Color fundus photograph: 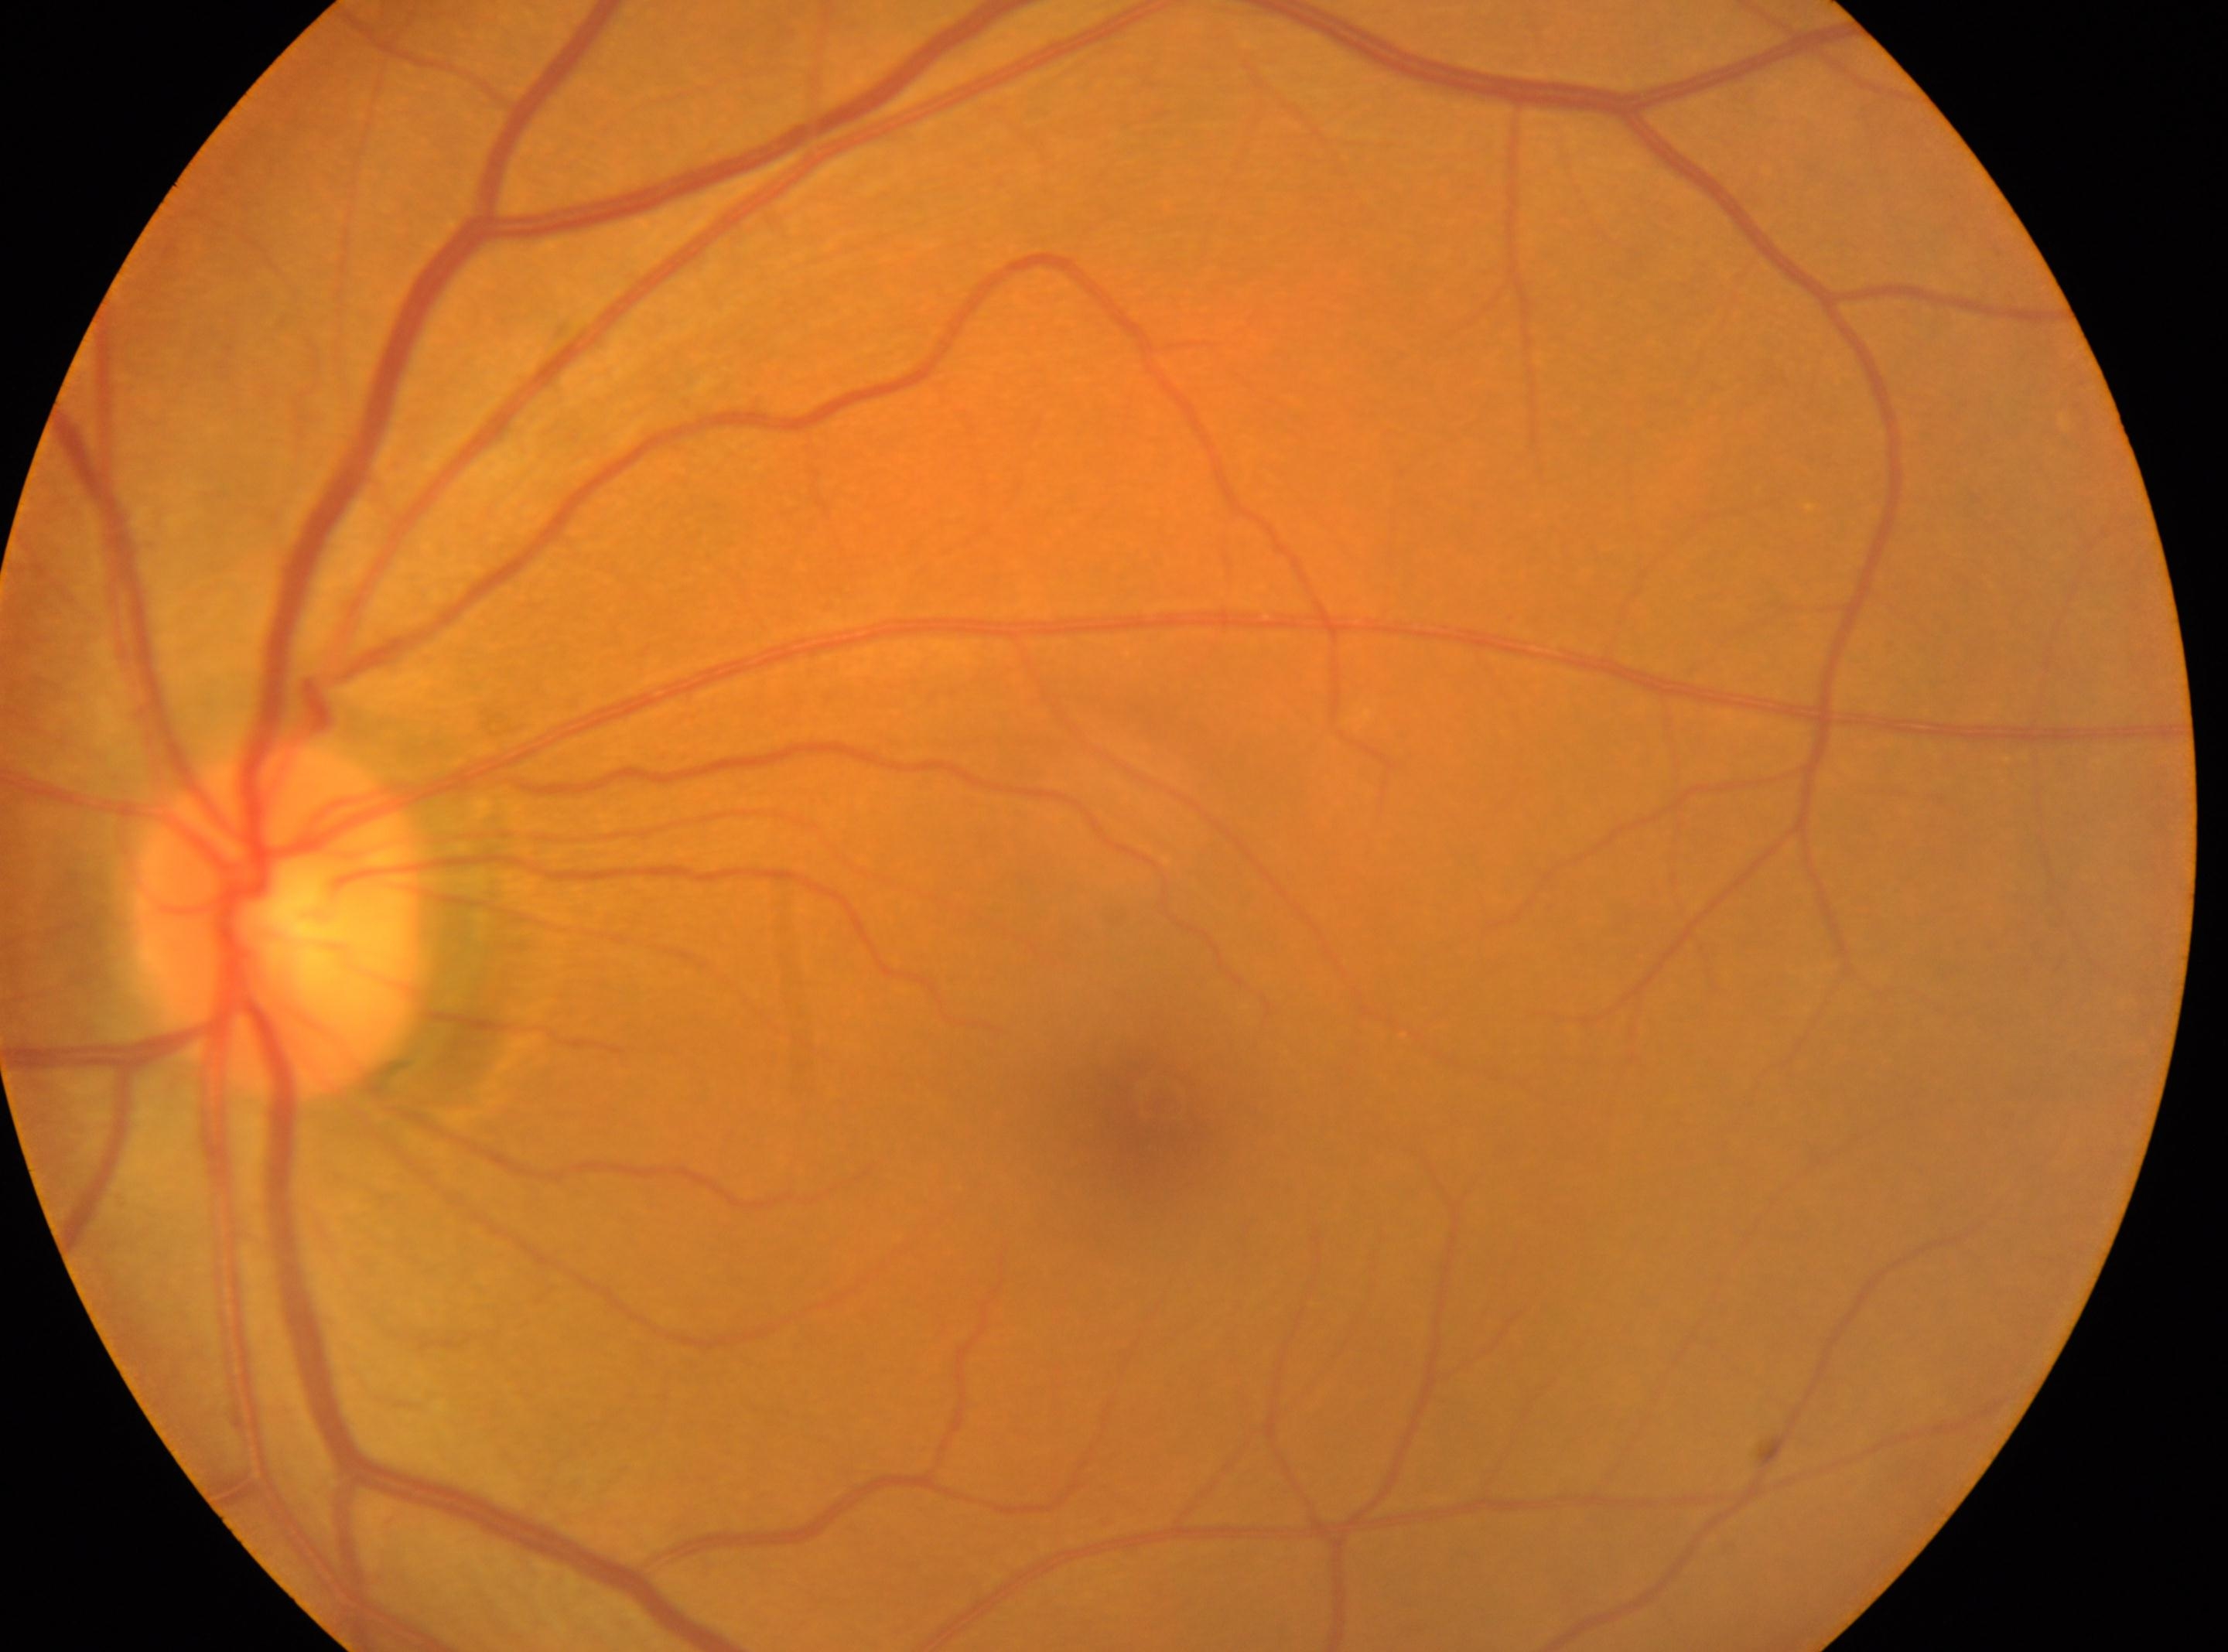

The optic disc is at [280, 920].
This is the OS.
DR stage is grade 0 (no apparent retinopathy).
Foveal center located at [1151, 1104].